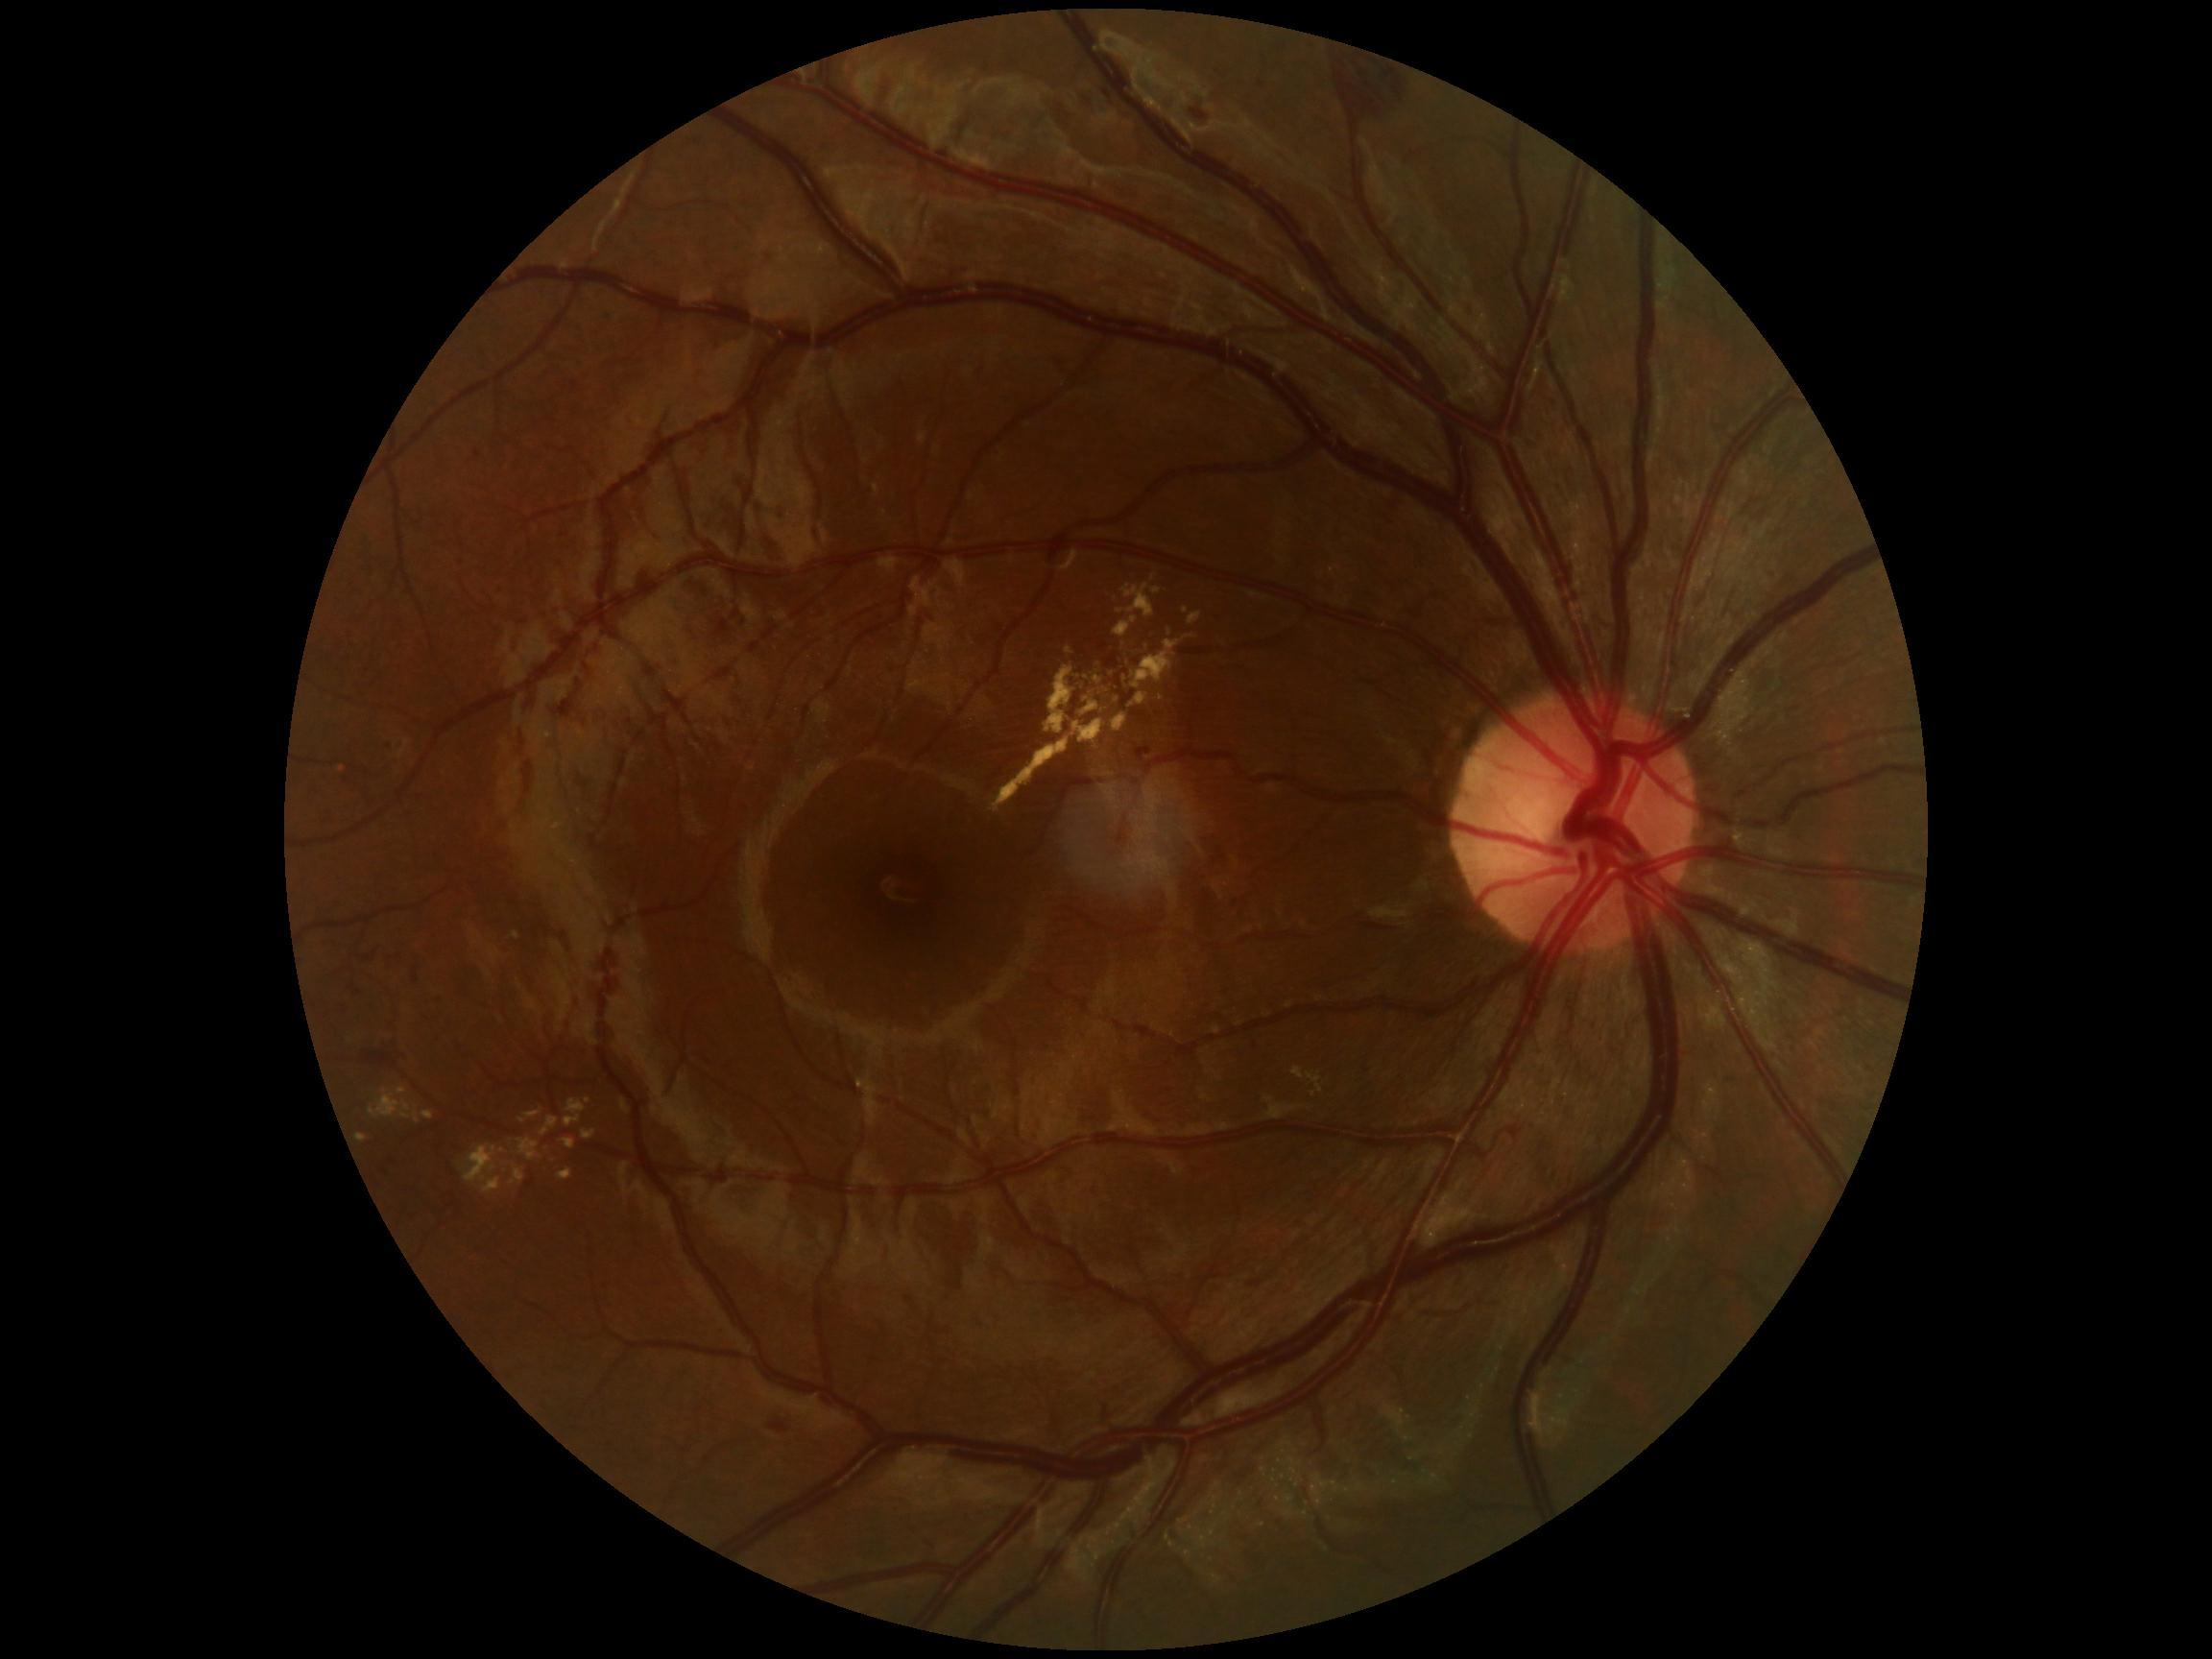
DR stage: moderate non-proliferative diabetic retinopathy (grade 2)
A subset of detected lesions:
EXs (continued): BBox(1122, 584, 1156, 619), BBox(1114, 617, 1138, 638), BBox(1080, 701, 1099, 717), BBox(1307, 1073, 1324, 1094), BBox(558, 1169, 572, 1181), BBox(356, 1135, 367, 1142), BBox(1078, 675, 1094, 685), BBox(512, 932, 519, 940), BBox(1111, 696, 1122, 708), BBox(462, 1145, 507, 1195)
Additional small EXs near [1012, 660], [1154, 579], [589, 1101], [1186, 611], [1161, 698]